Fundus photo:
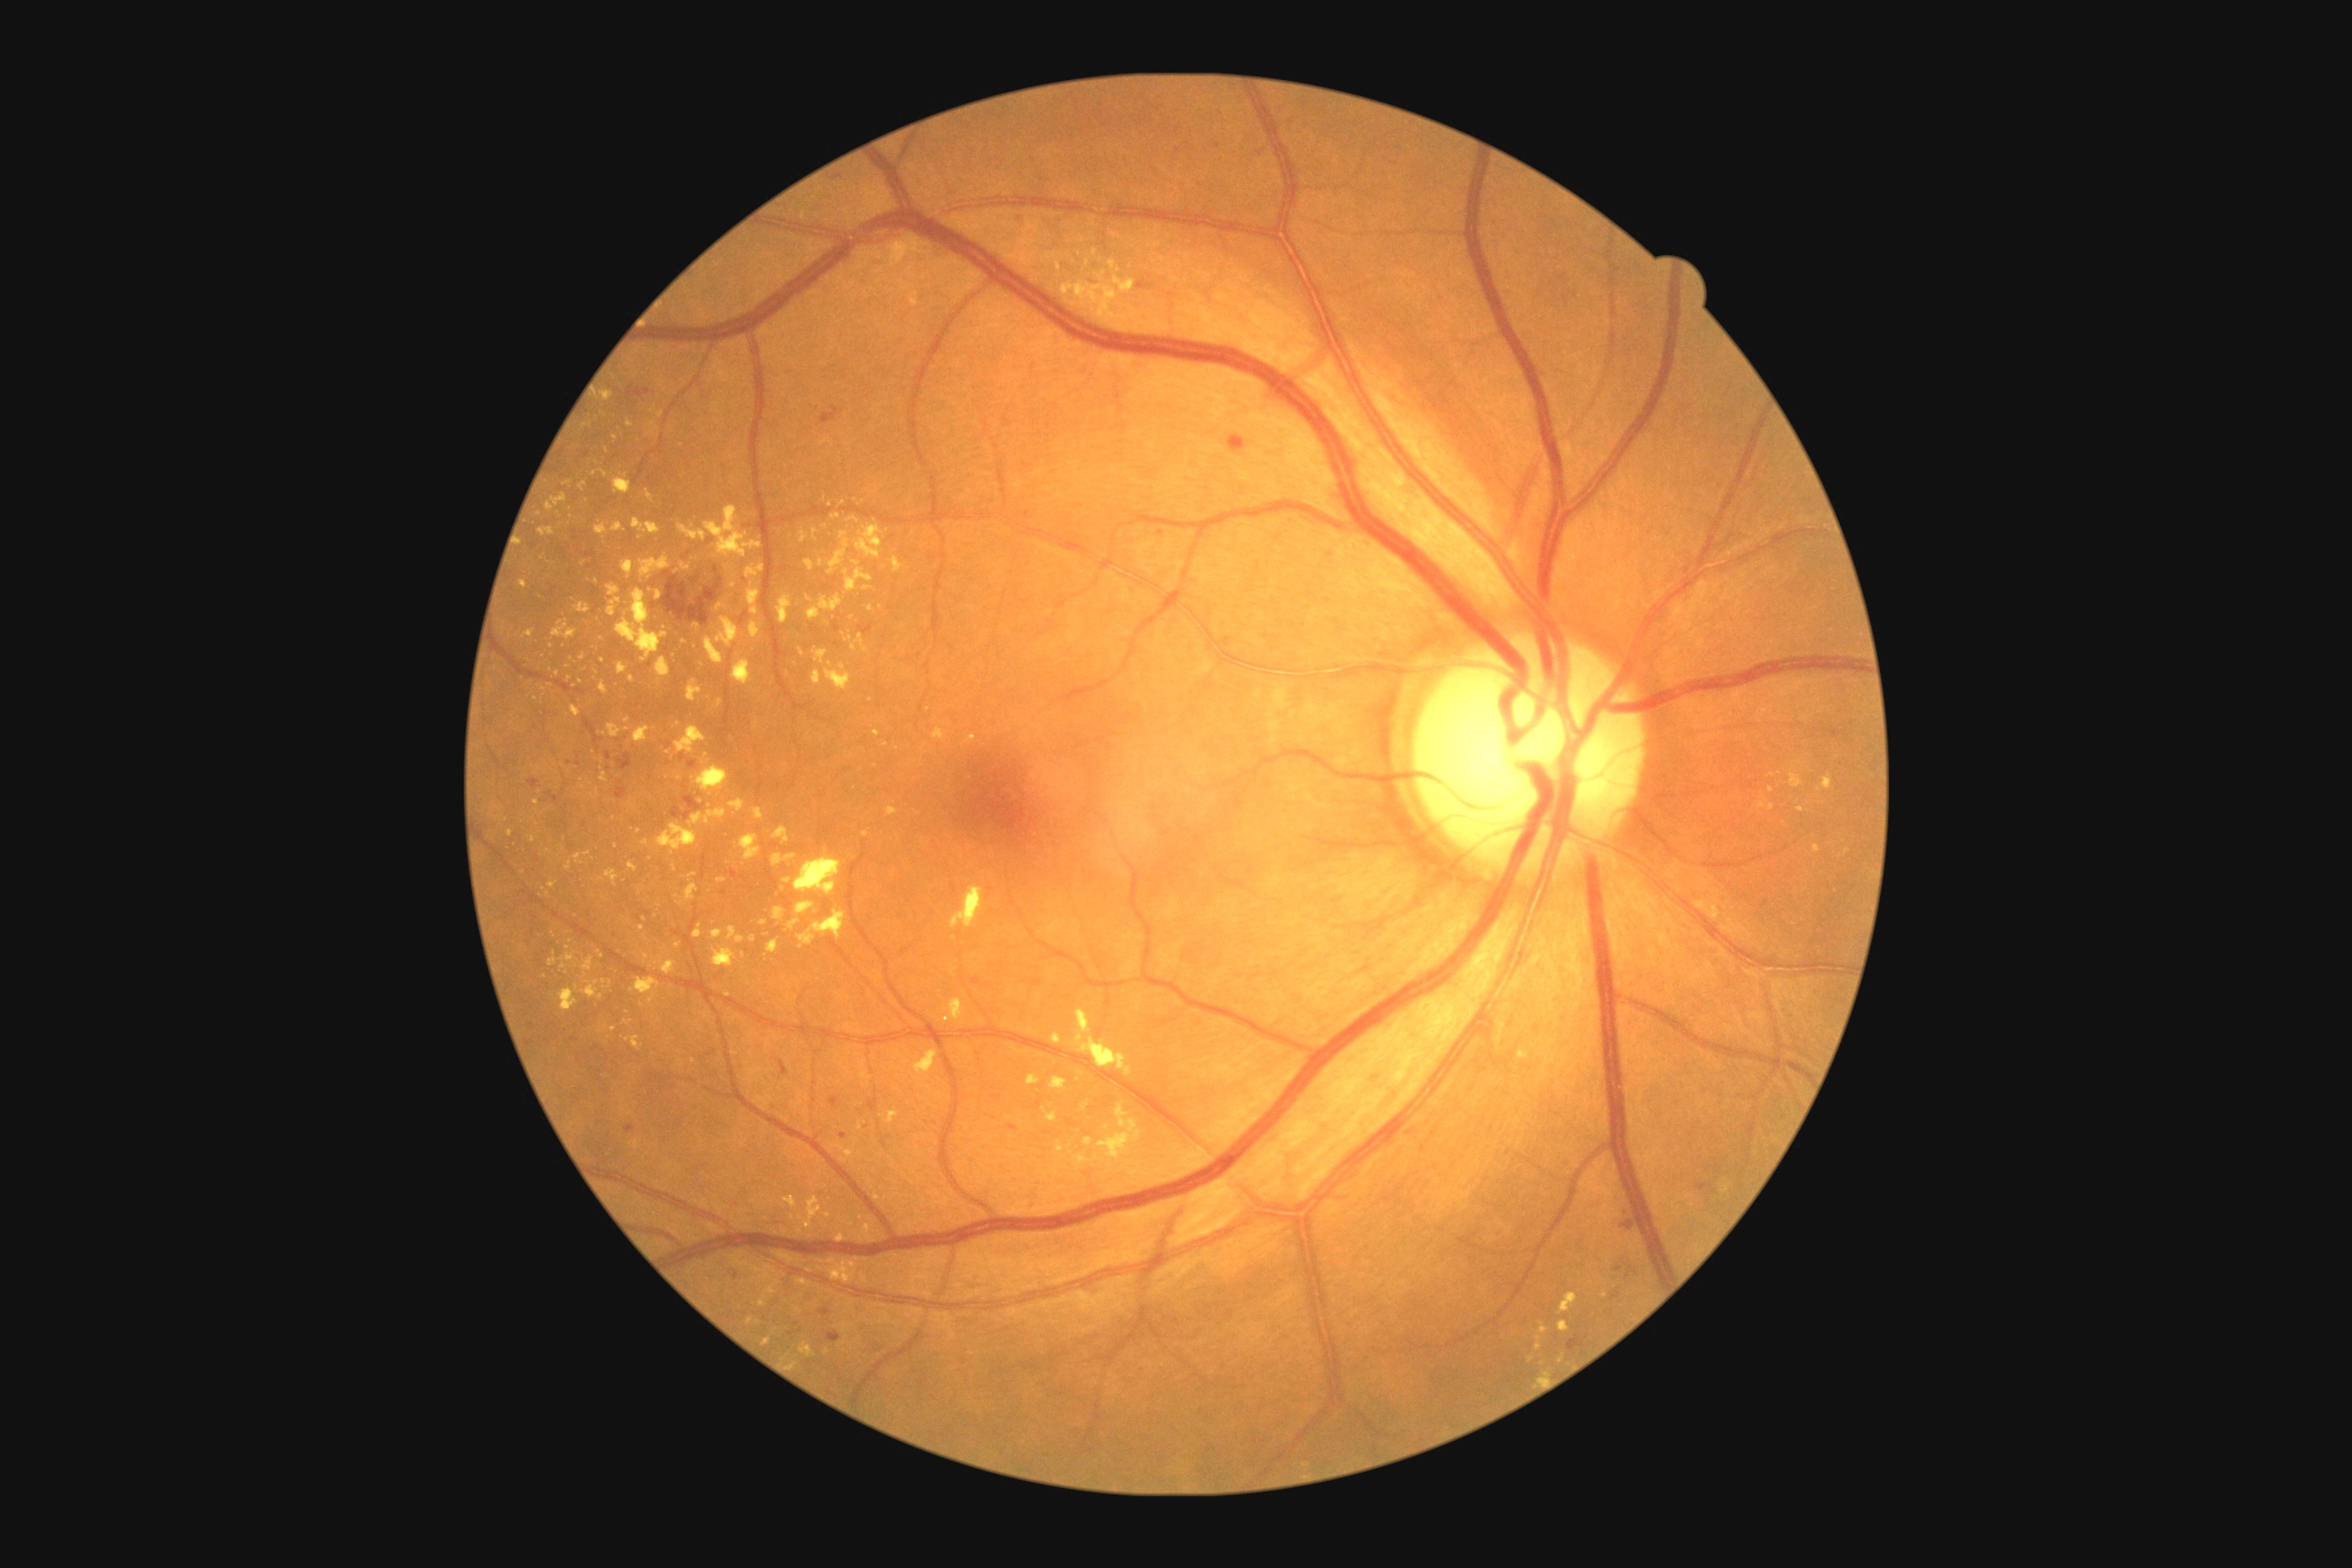
partial: true
dr_grade: 2
dr_grade_name: moderate NPDR
lesions:
  ex:
    - [left=689, top=872, right=698, bottom=881]
    - [left=950, top=887, right=985, bottom=930]
    - [left=763, top=1338, right=770, bottom=1346]
    - [left=845, top=1023, right=854, bottom=1030]
    - [left=1560, top=1293, right=1578, bottom=1315]
    - [left=740, top=836, right=761, bottom=861]
    - [left=812, top=529, right=818, bottom=538]
    - [left=594, top=524, right=609, bottom=536]
    - [left=602, top=391, right=614, bottom=402]
    - [left=685, top=885, right=700, bottom=903]
    - [left=799, top=531, right=808, bottom=544]
  ex_small:
    - (x=500, y=810)
    - (x=627, y=1013)
    - (x=828, y=1216)
    - (x=1081, y=1074)
    - (x=602, y=880)
    - (x=825, y=500)
    - (x=1547, y=1375)
    - (x=584, y=563)